2212x1659 · CFP.
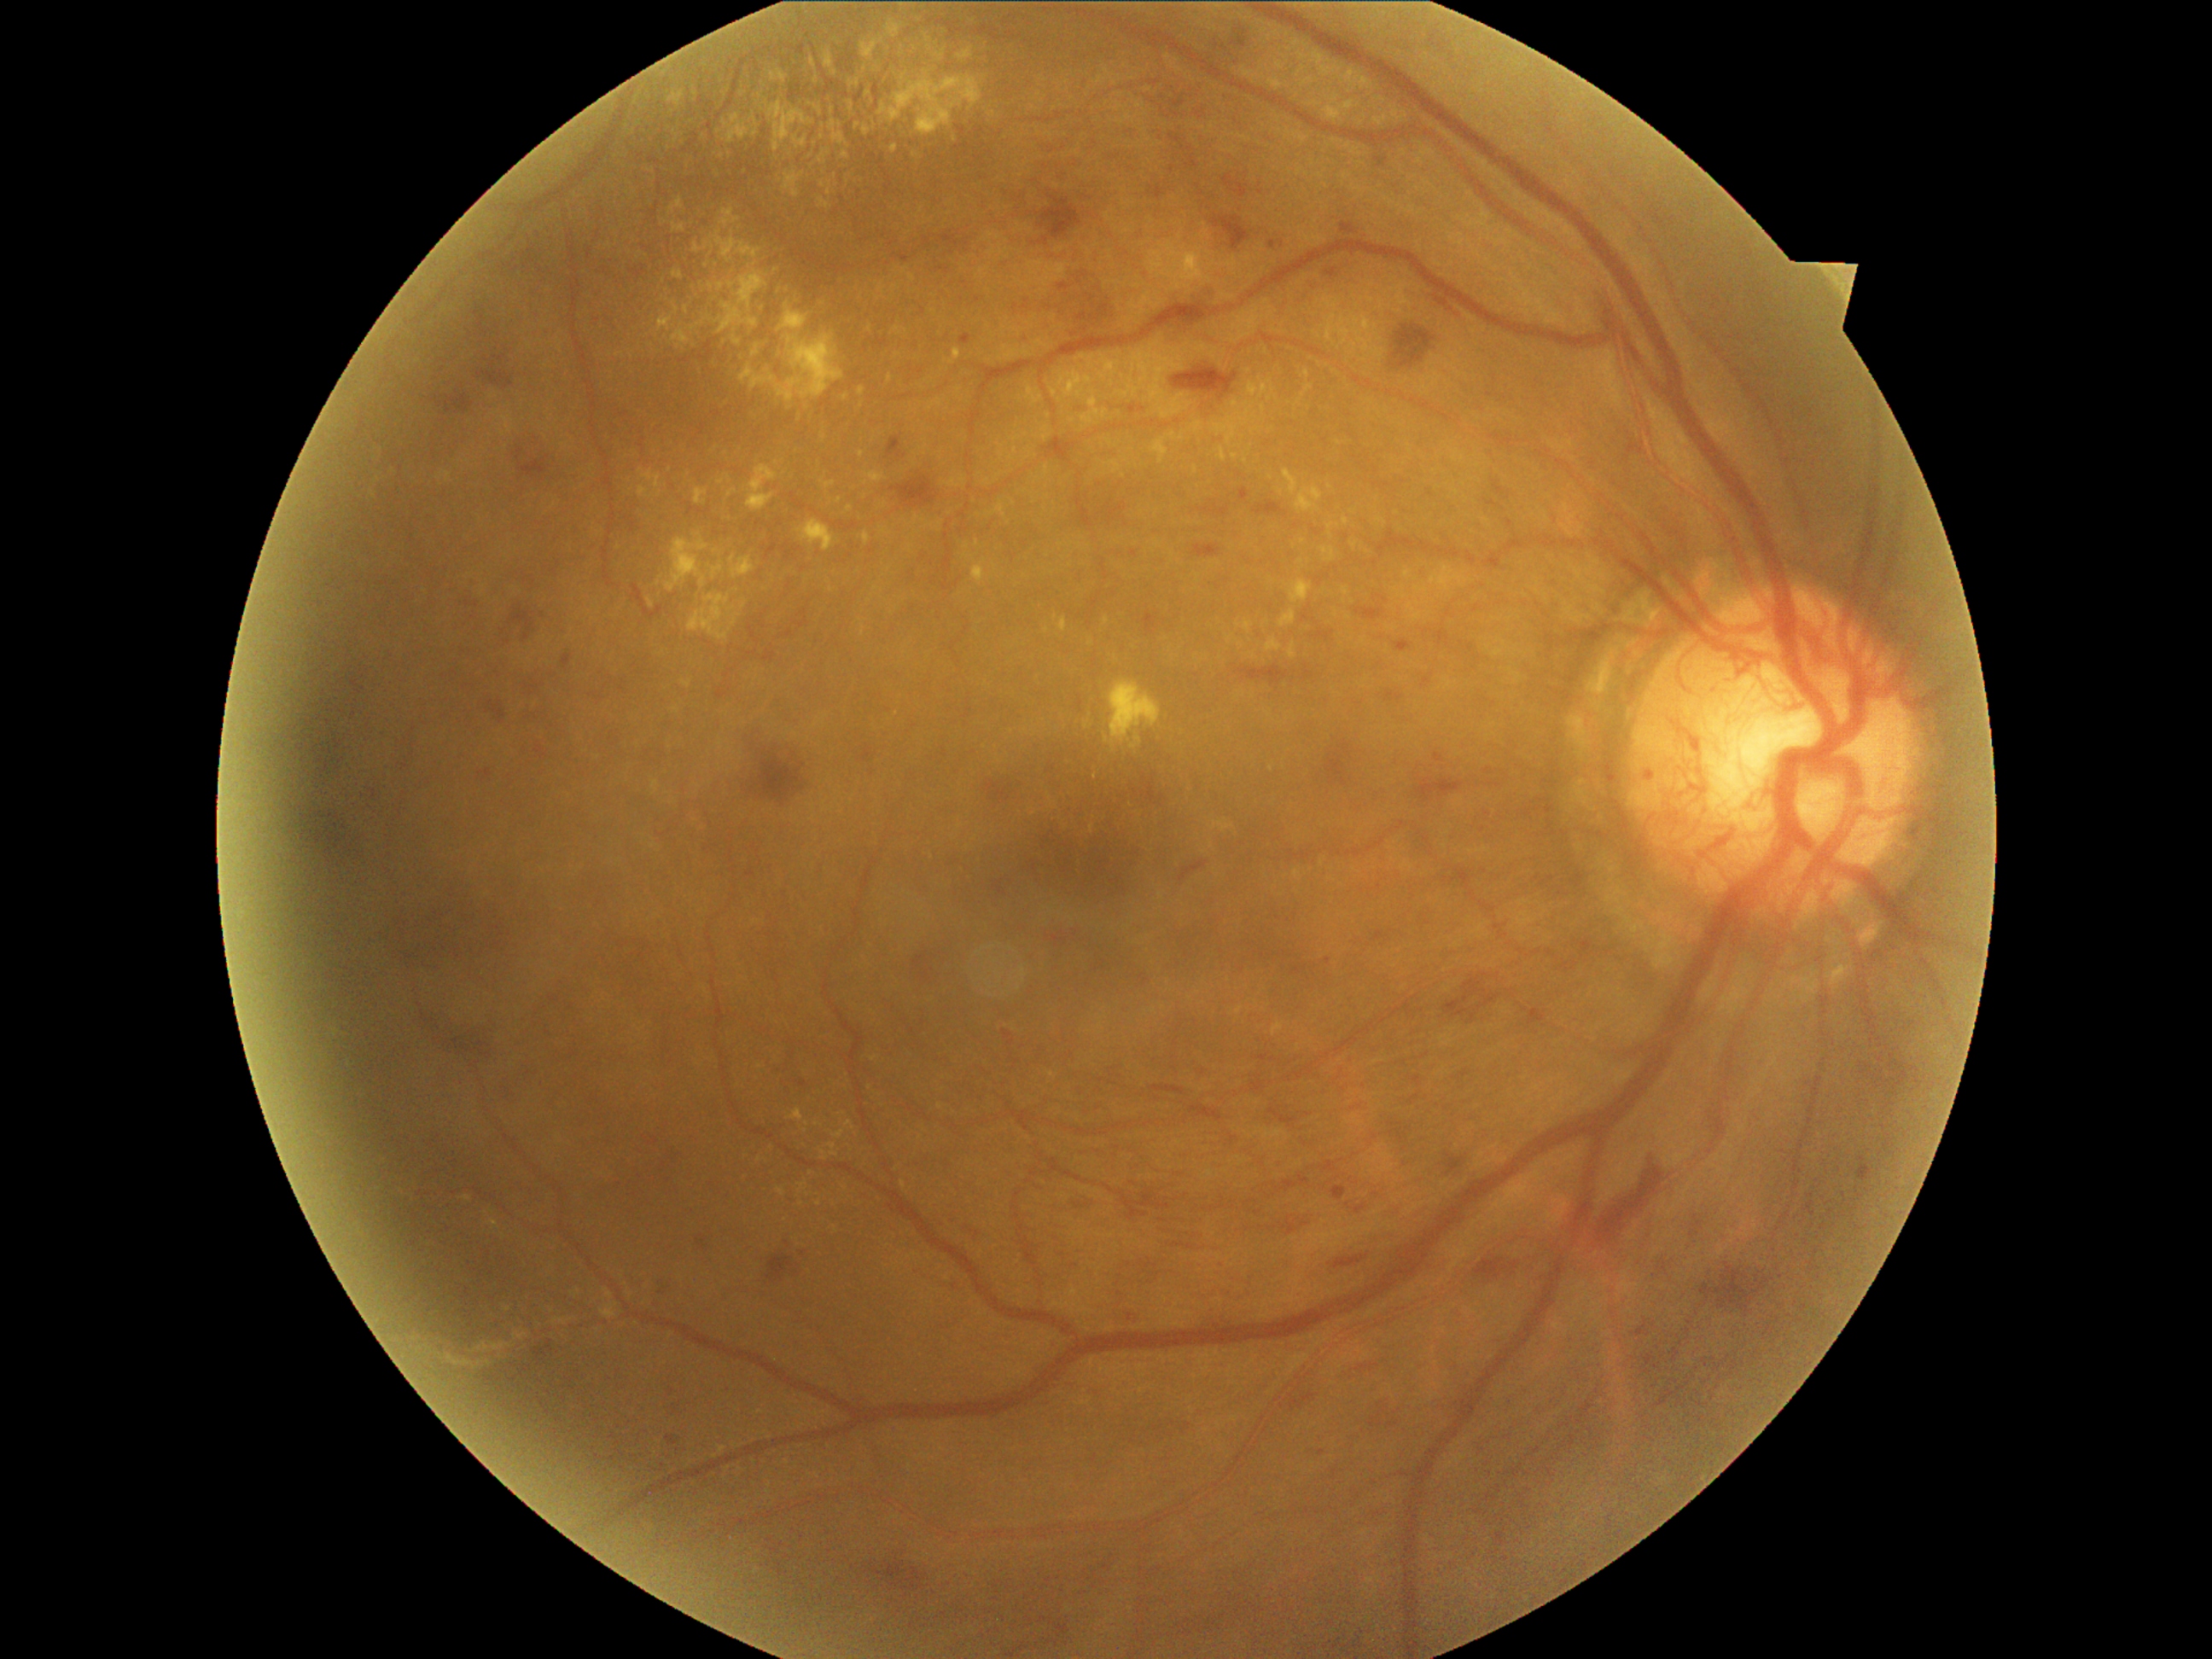 Diabetic retinopathy (DR) is grade 4 (PDR)
Representative lesions:
hard exudates (EXs) (more not shown): BBox(829, 1144, 837, 1150); BBox(818, 199, 829, 207); BBox(1199, 422, 1204, 433); BBox(714, 233, 760, 264); BBox(692, 318, 713, 332); BBox(771, 71, 789, 83); BBox(477, 1342, 489, 1351); BBox(651, 781, 660, 795); BBox(1324, 102, 1354, 122); BBox(958, 50, 974, 61); BBox(718, 282, 725, 291); BBox(1361, 349, 1370, 358); BBox(779, 88, 796, 100); BBox(707, 561, 725, 581)
Small EXs near [696,94]; [863,454]; [1306,45]; [745,606]; [832,111]; [1307,374]